Modified Davis grading. CFP
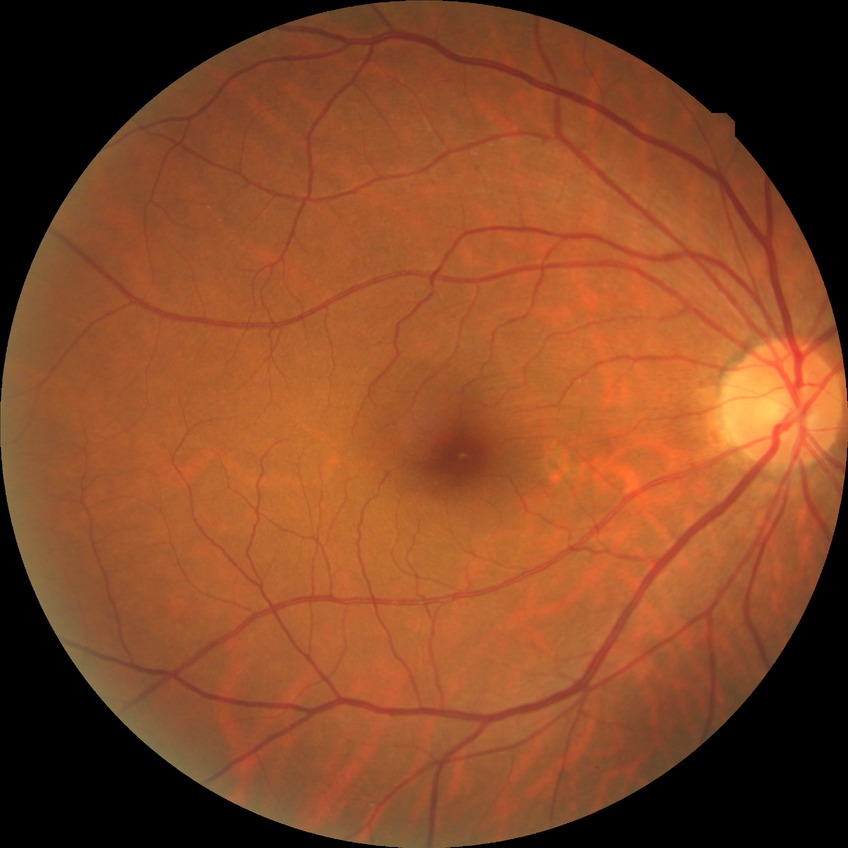 diabetic retinopathy (DR) = NDR (no diabetic retinopathy).